Wide-field fundus photograph from neonatal ROP screening
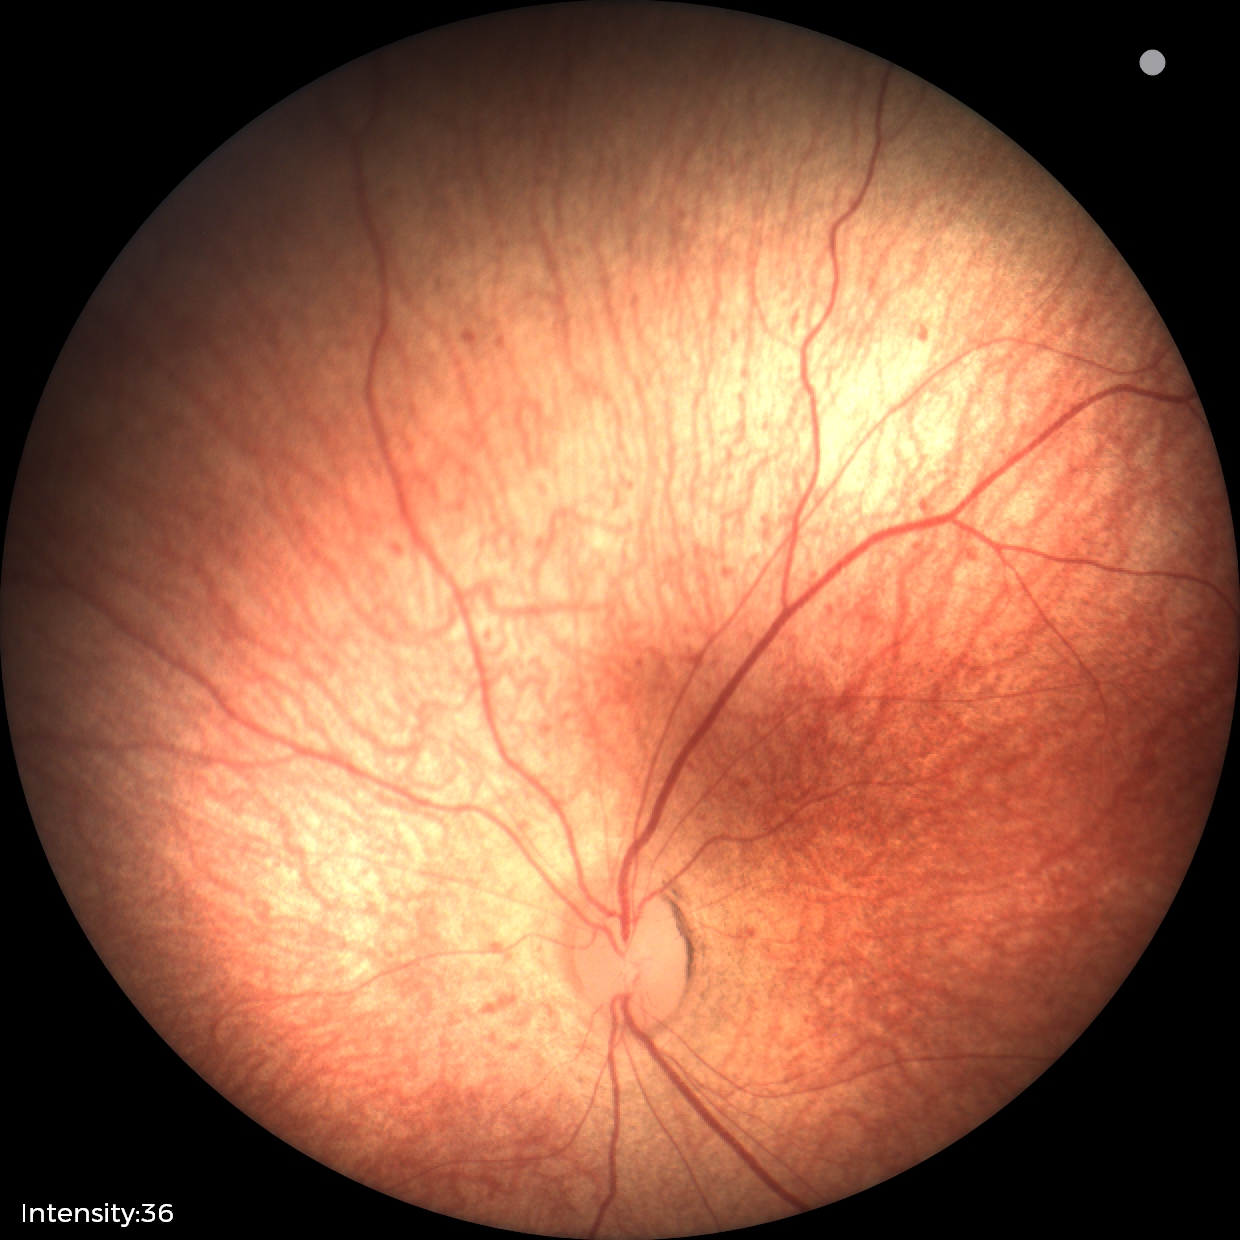 Screening diagnosis: physiological appearance with no retinal pathology.